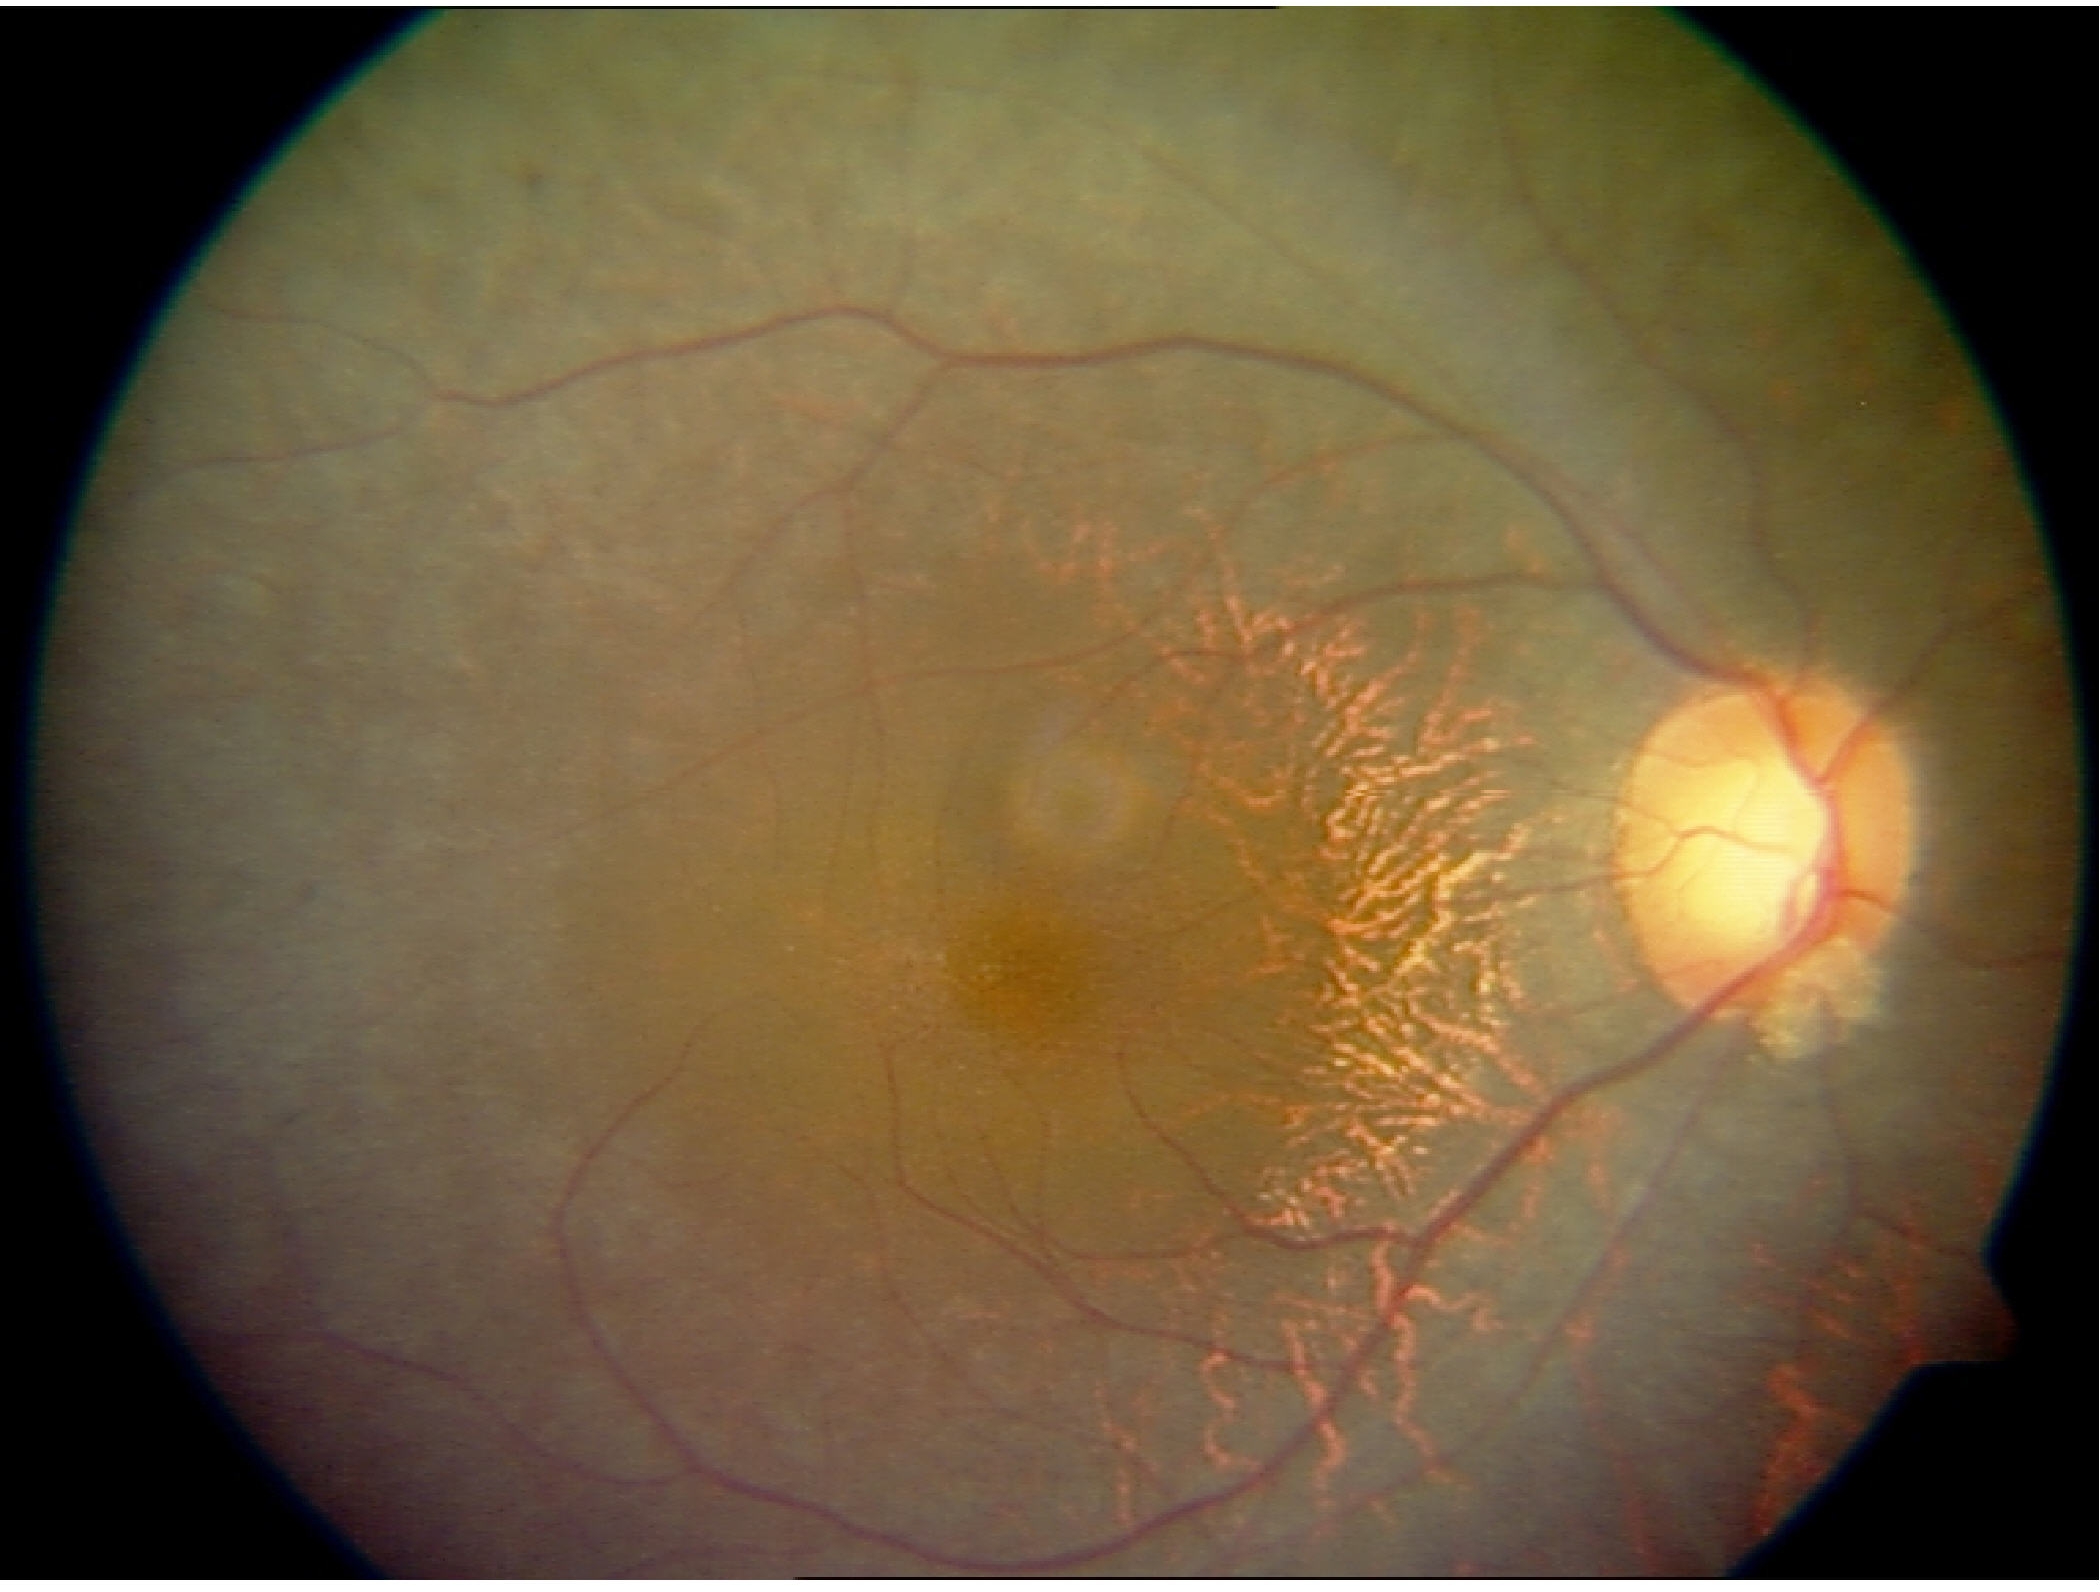
The image shows retinitis pigmentosa. Typically showing mid-peripheral retinal pigment epithelium atrophy with bone-spicule perivascular pigmentation, arteriolar attenuation, and waxy disc pallor.